Without pupil dilation. Color fundus photograph. 848 by 848 pixels. FOV: 45 degrees. Diabetic retinopathy graded by the modified Davis classification: 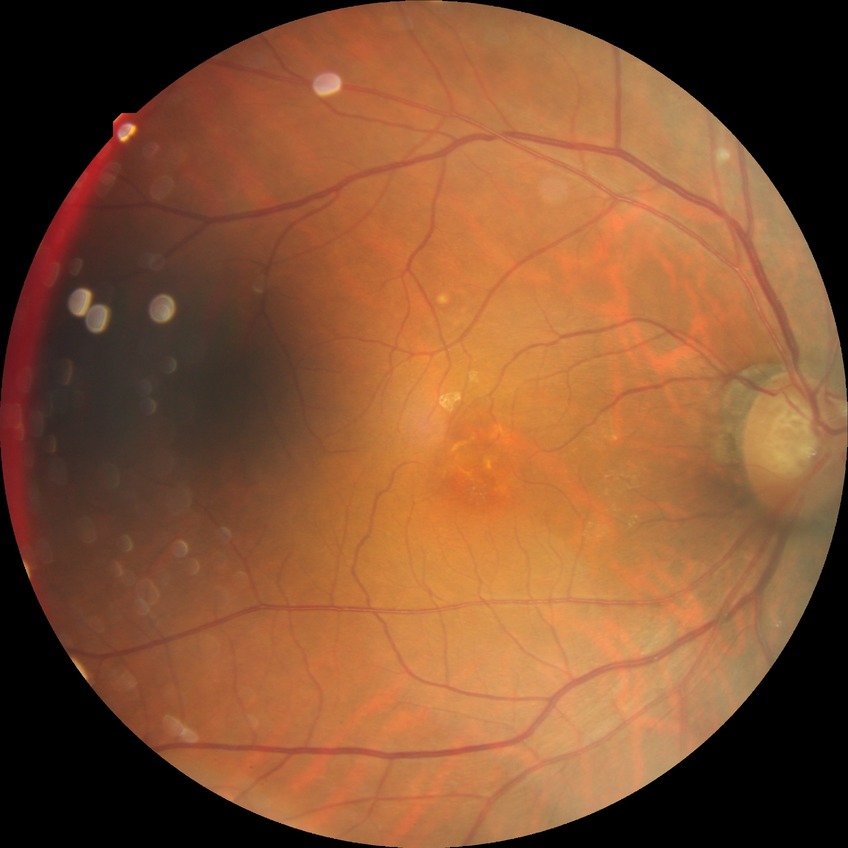

diabetic retinopathy grade: no diabetic retinopathy.